45 degree fundus photograph; 848x848px; nonmydriatic; color fundus photograph — 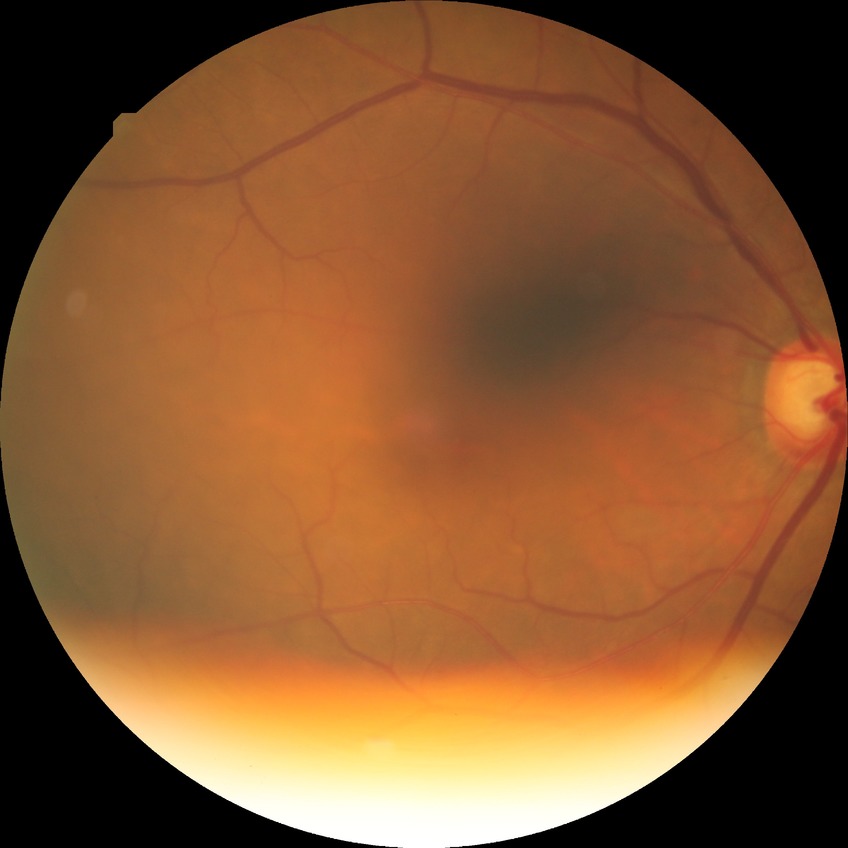 Diabetic retinopathy (DR): SDR (simple diabetic retinopathy).